Color fundus photograph: 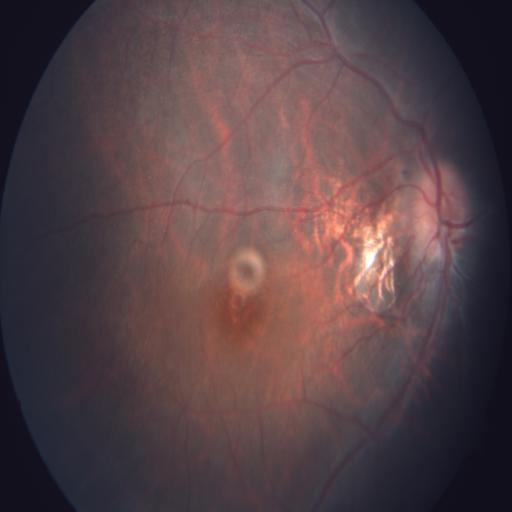 Findings: optic disc edema (ODE).